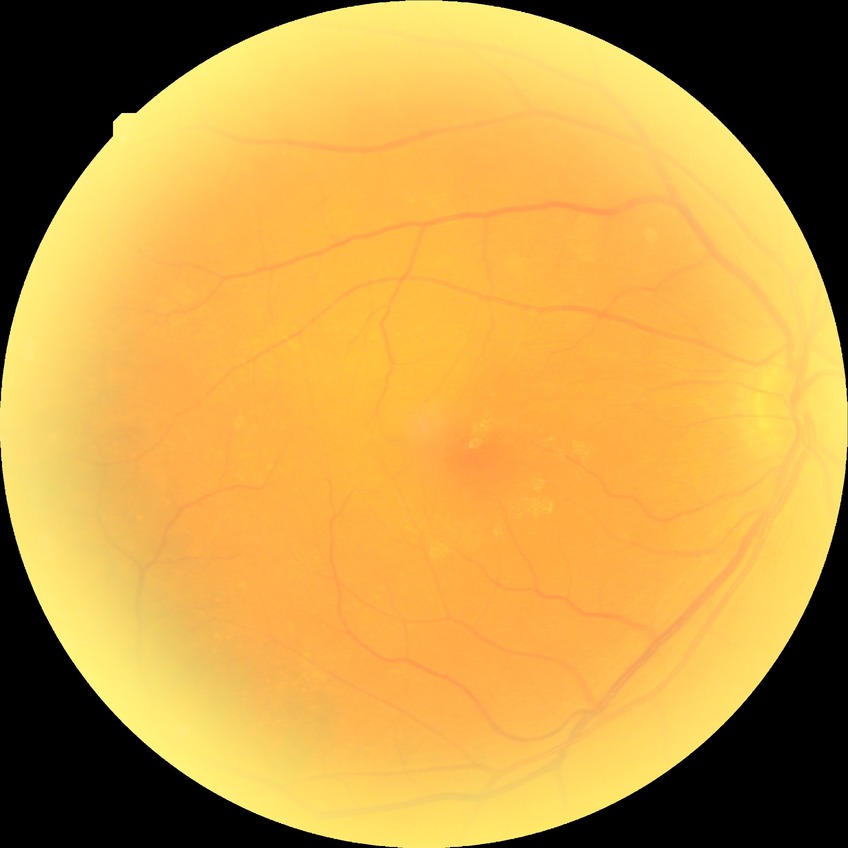
Diabetic retinopathy (DR): no diabetic retinopathy (NDR).